Color fundus photograph; Davis DR grading: 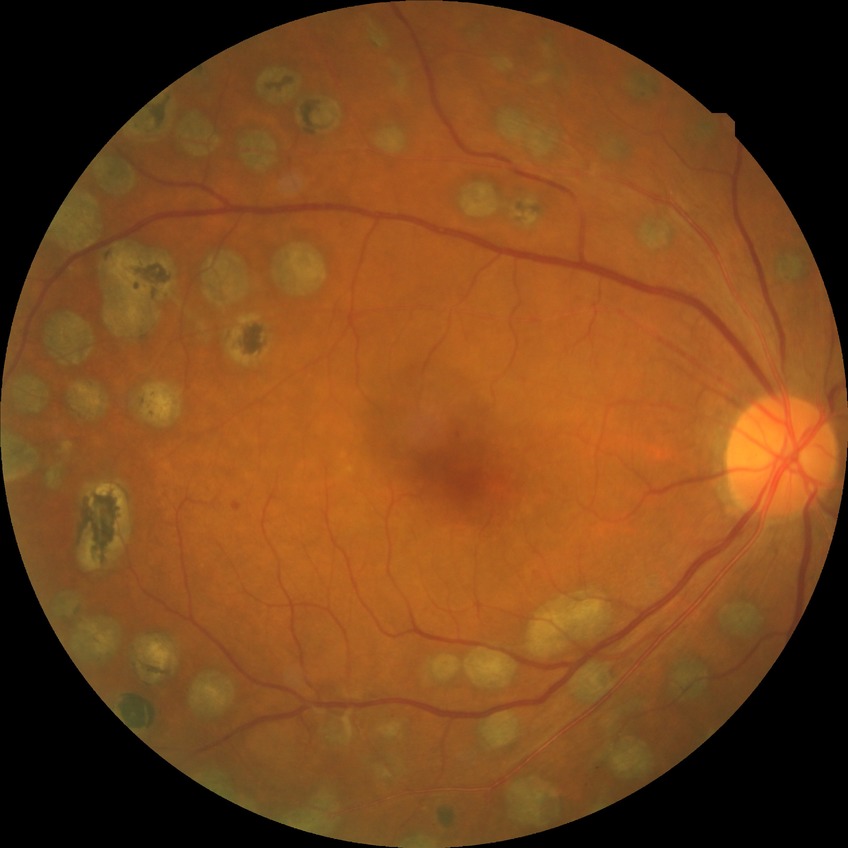

diabetic retinopathy (DR)=PDR (proliferative diabetic retinopathy).